45-degree field of view · NIDEK AFC-230 fundus camera — 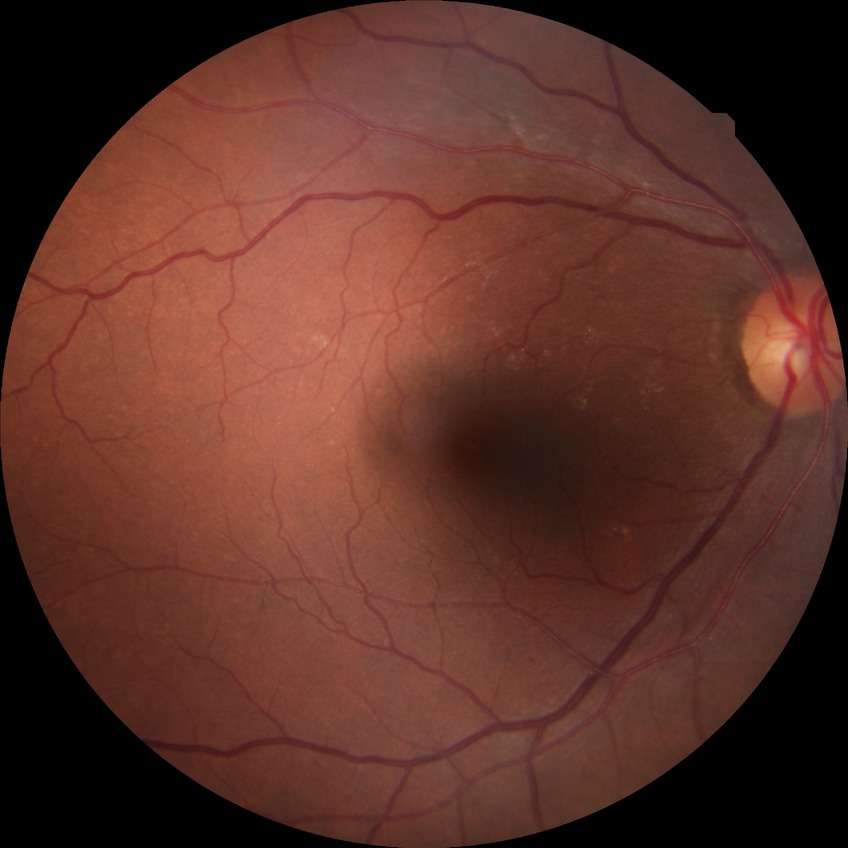

{
  "davis_grade": "no diabetic retinopathy"
}